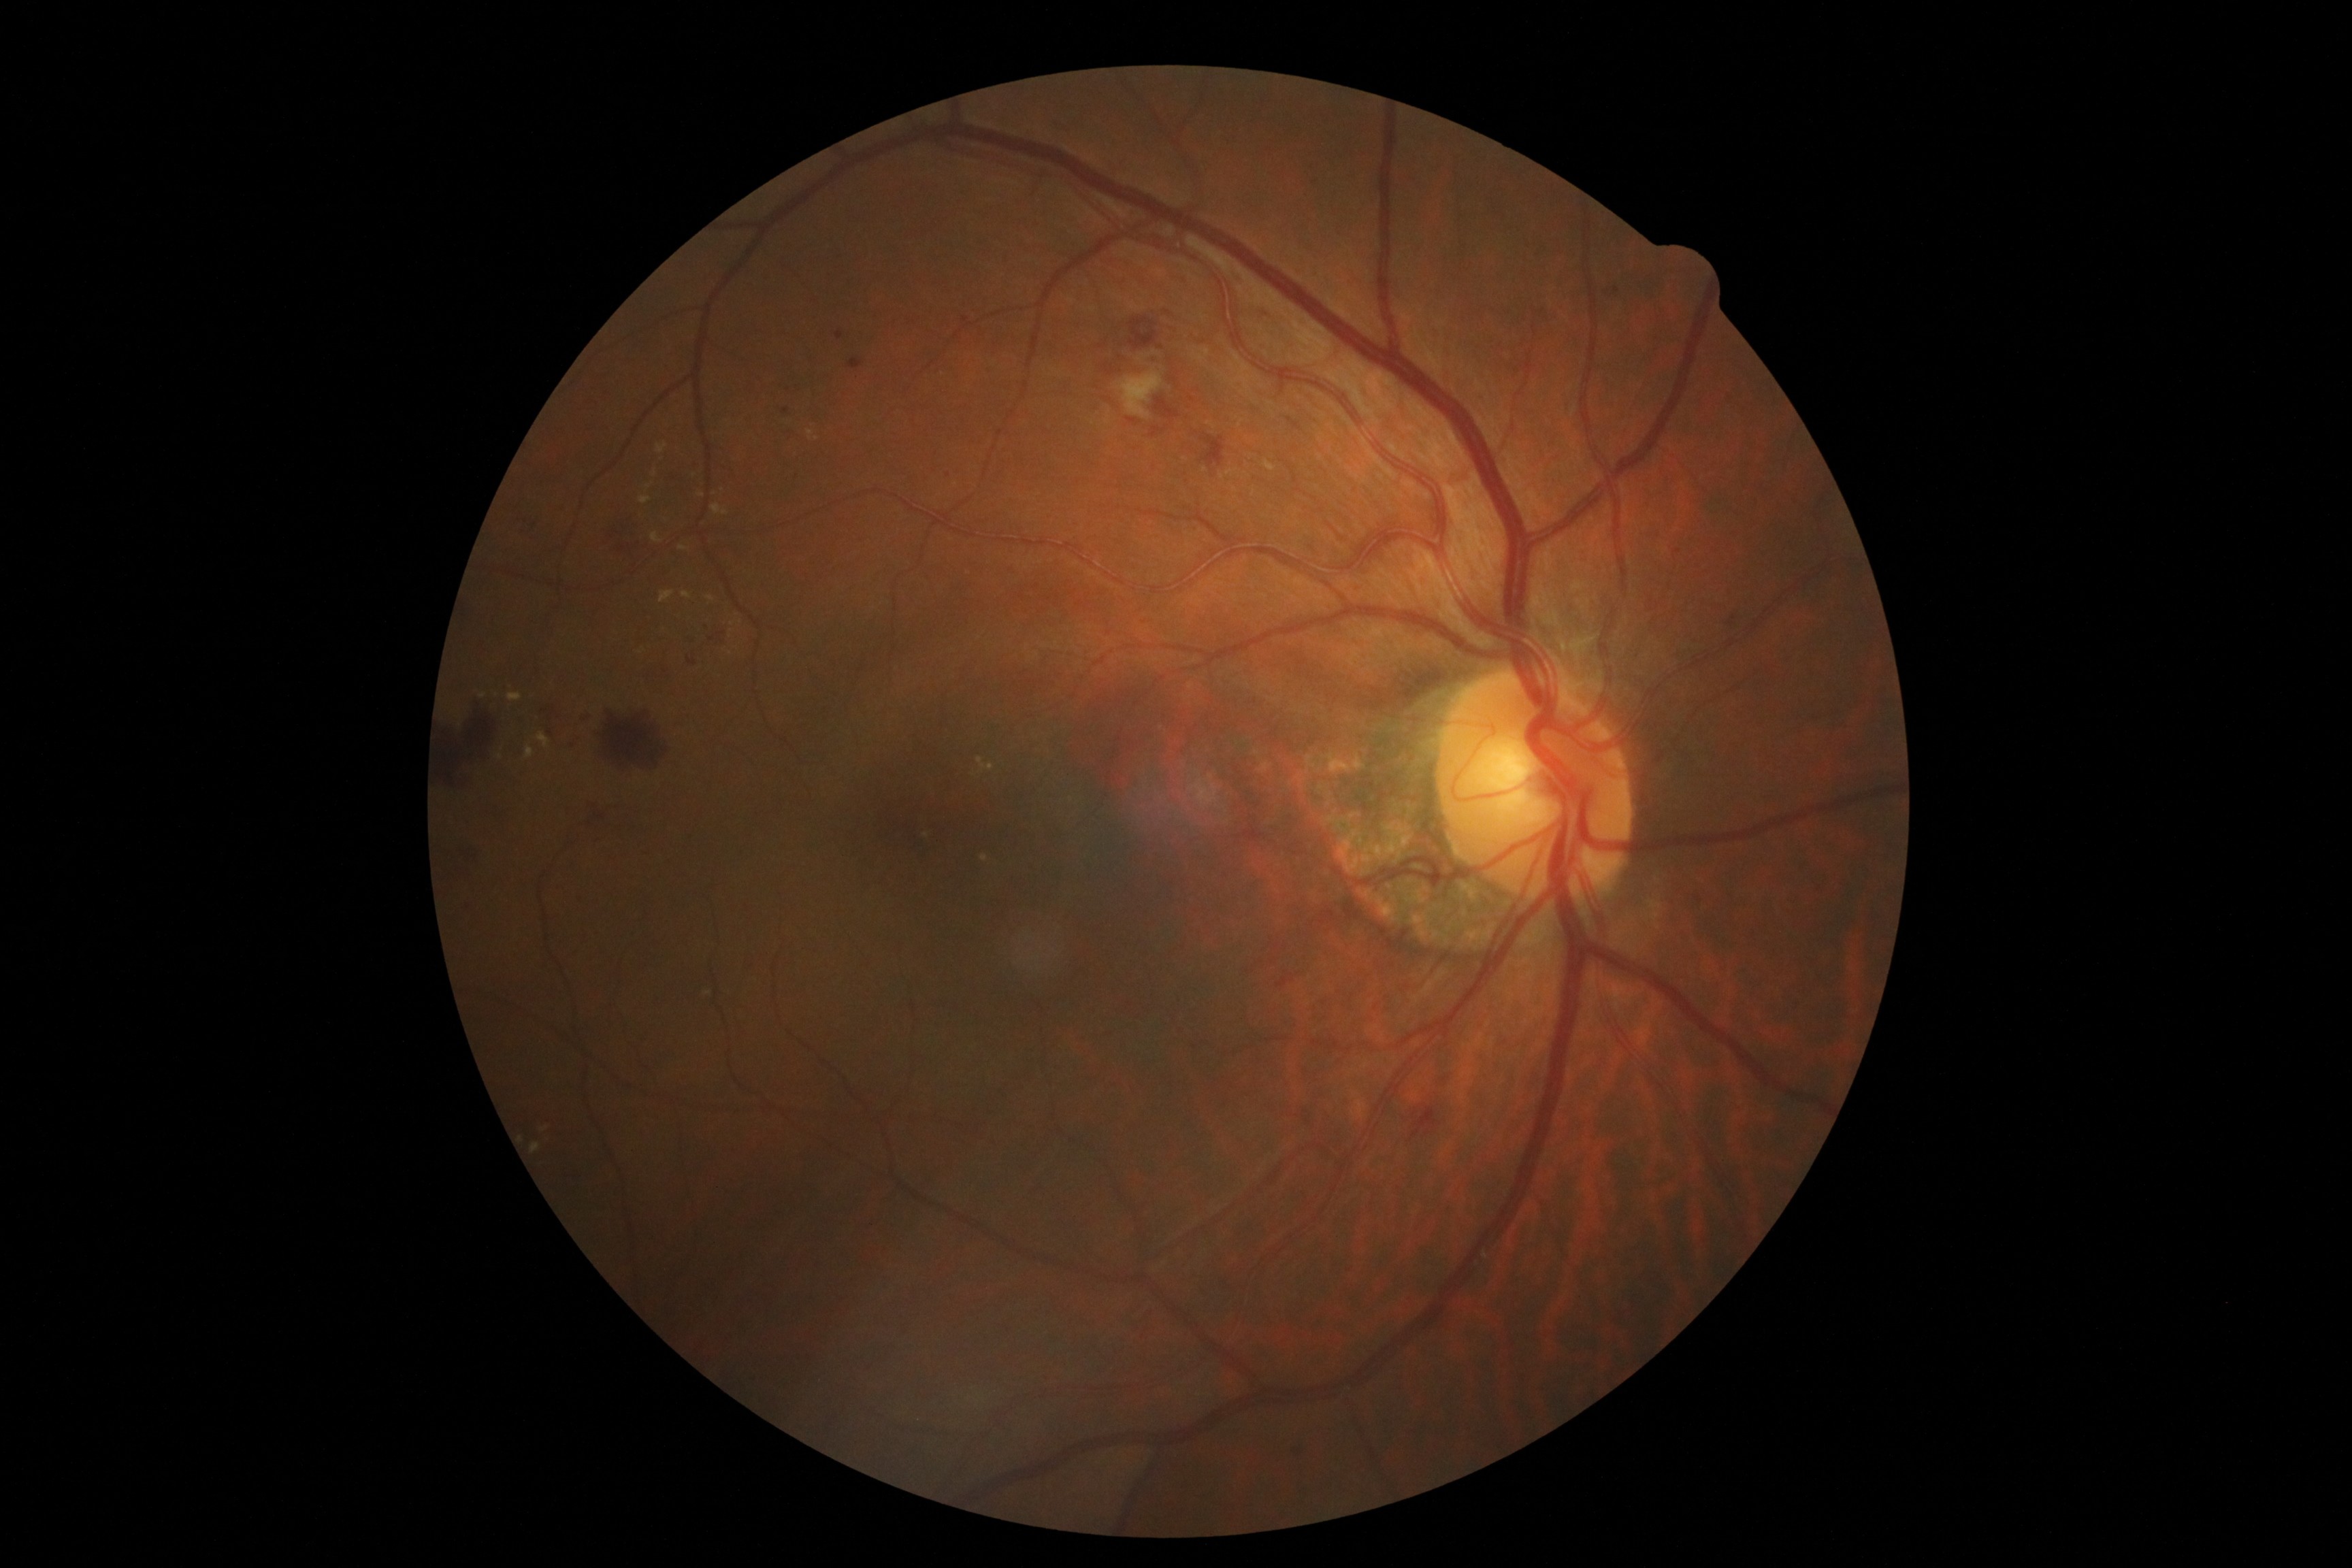 dr_grade: moderate NPDR (2)